130° field of view (Clarity RetCam 3); wide-field fundus photograph from neonatal ROP screening
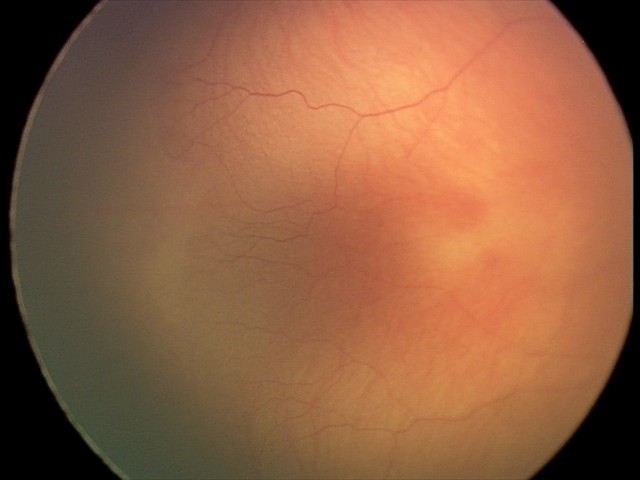
Diagnosis from this screening exam: ROP stage 2.